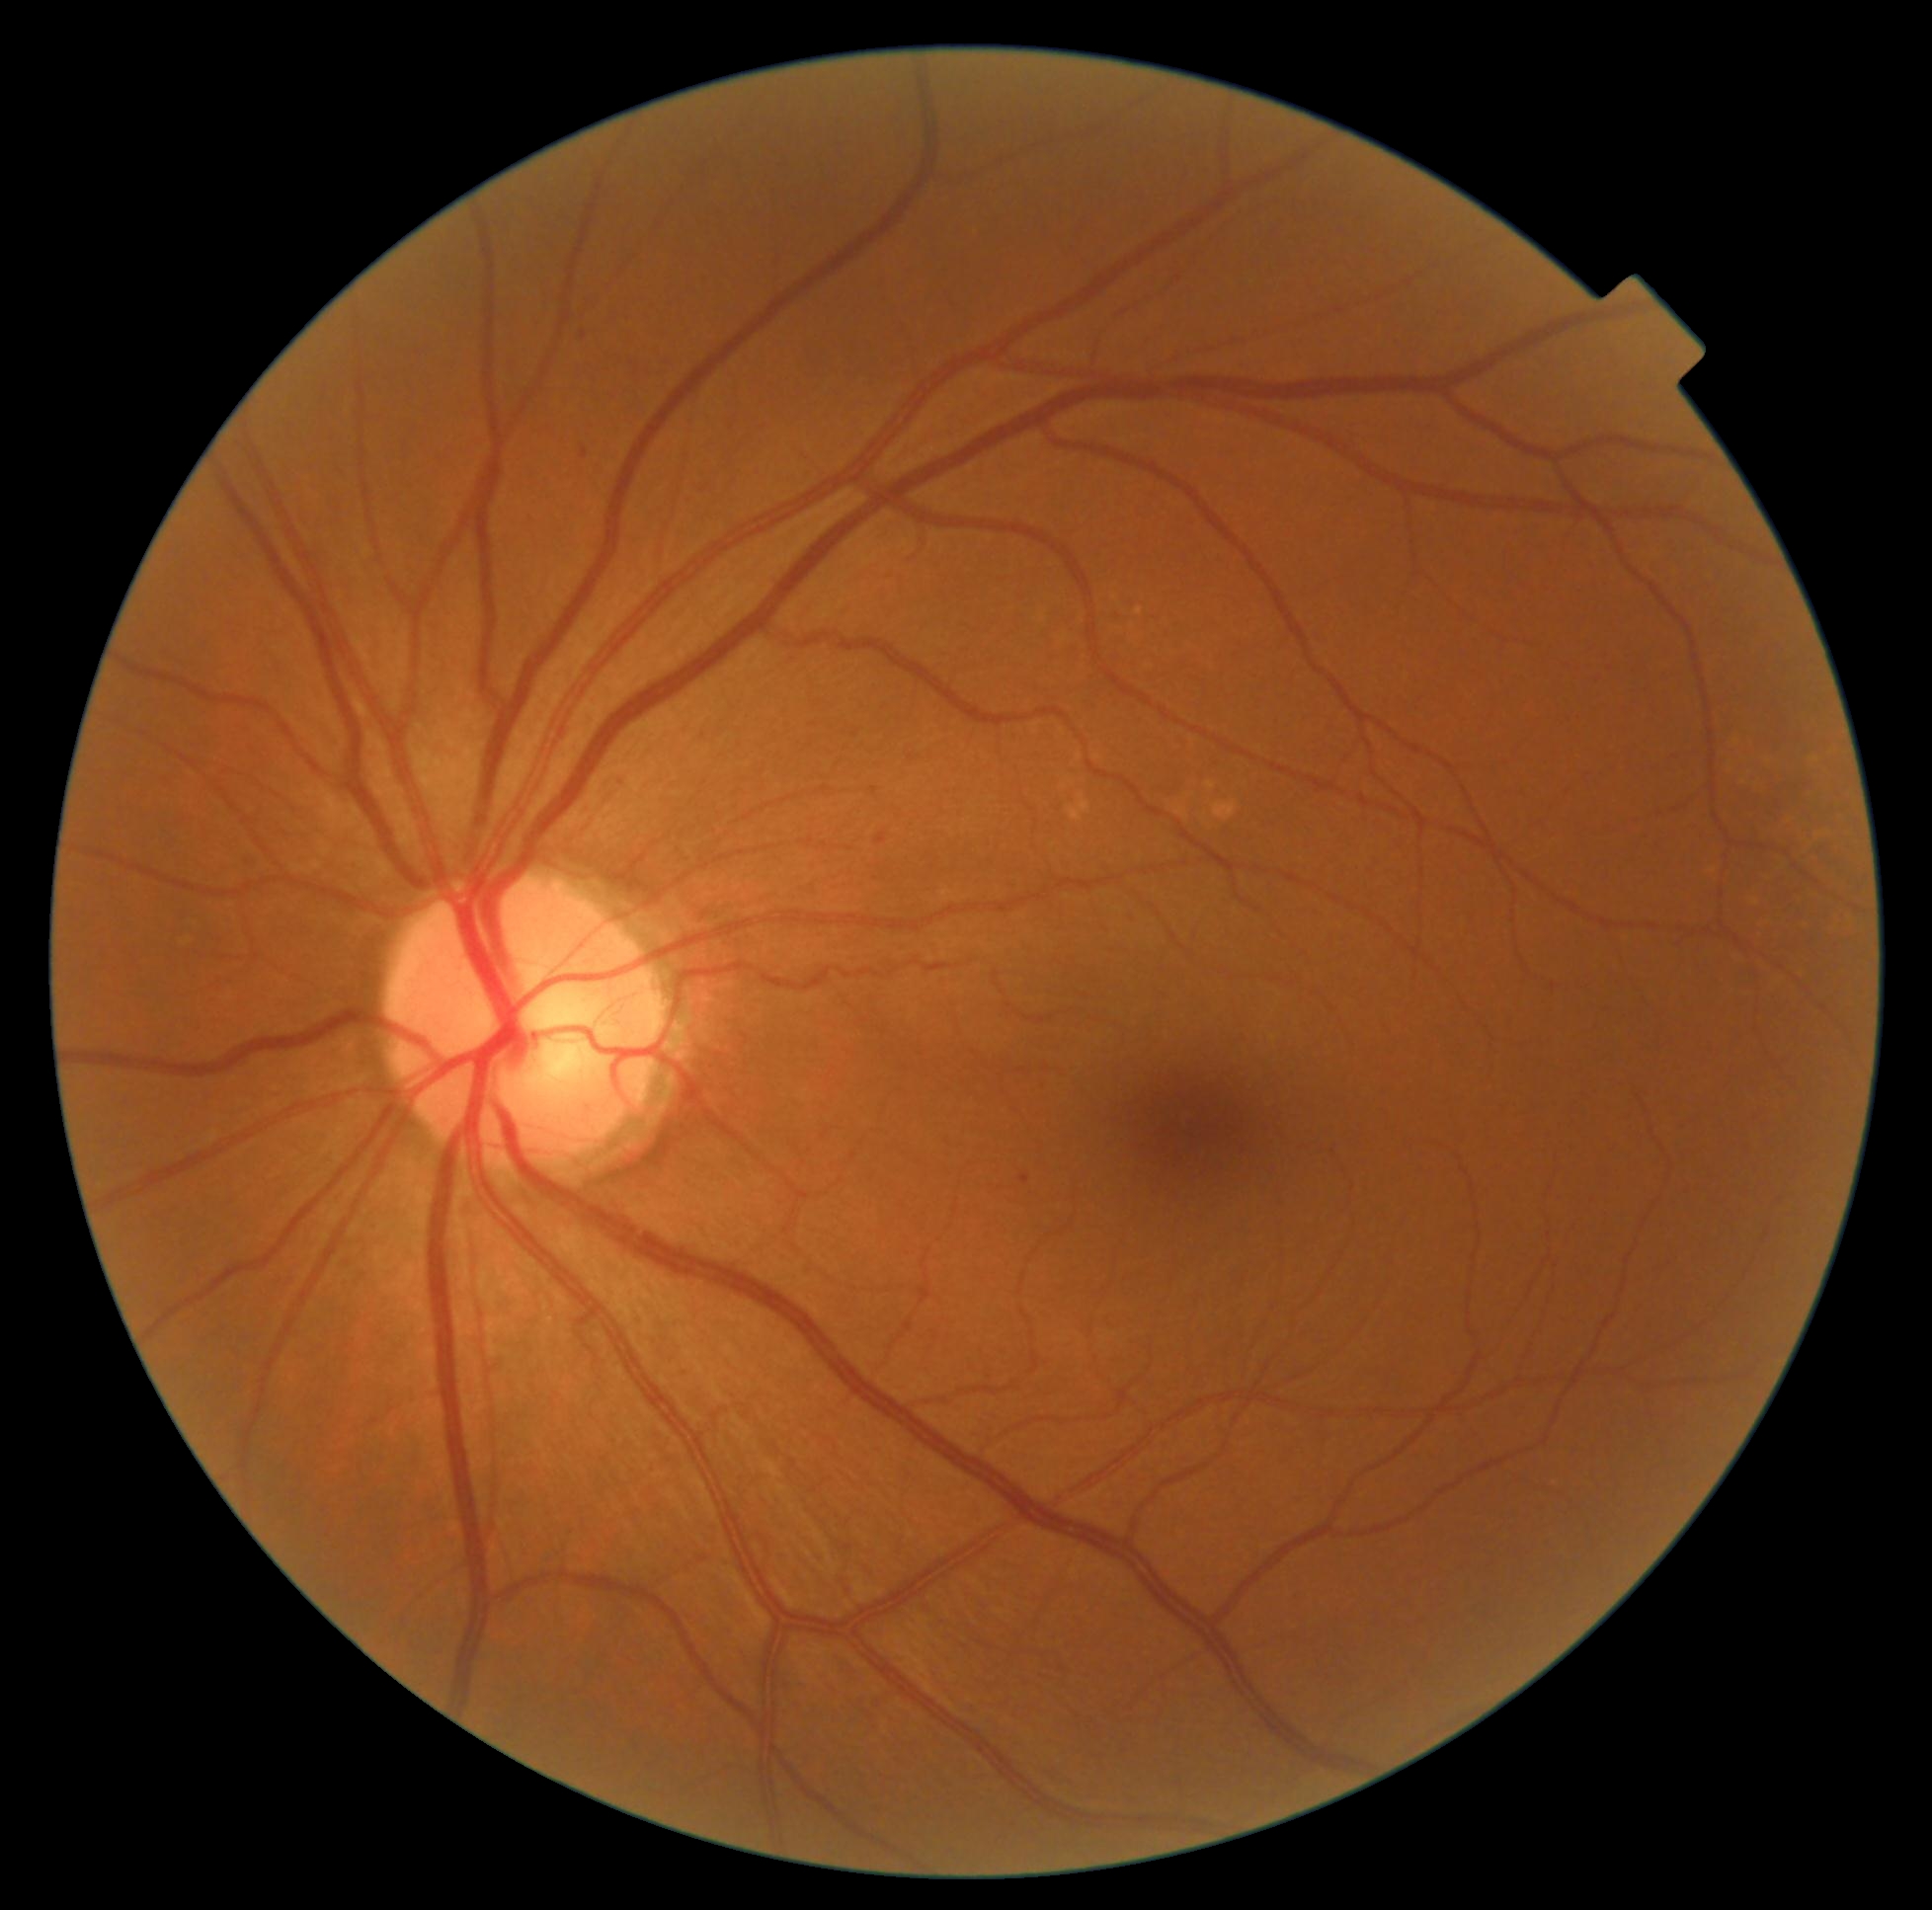

DR stage: grade 1 (mild NPDR).